Color fundus photograph — 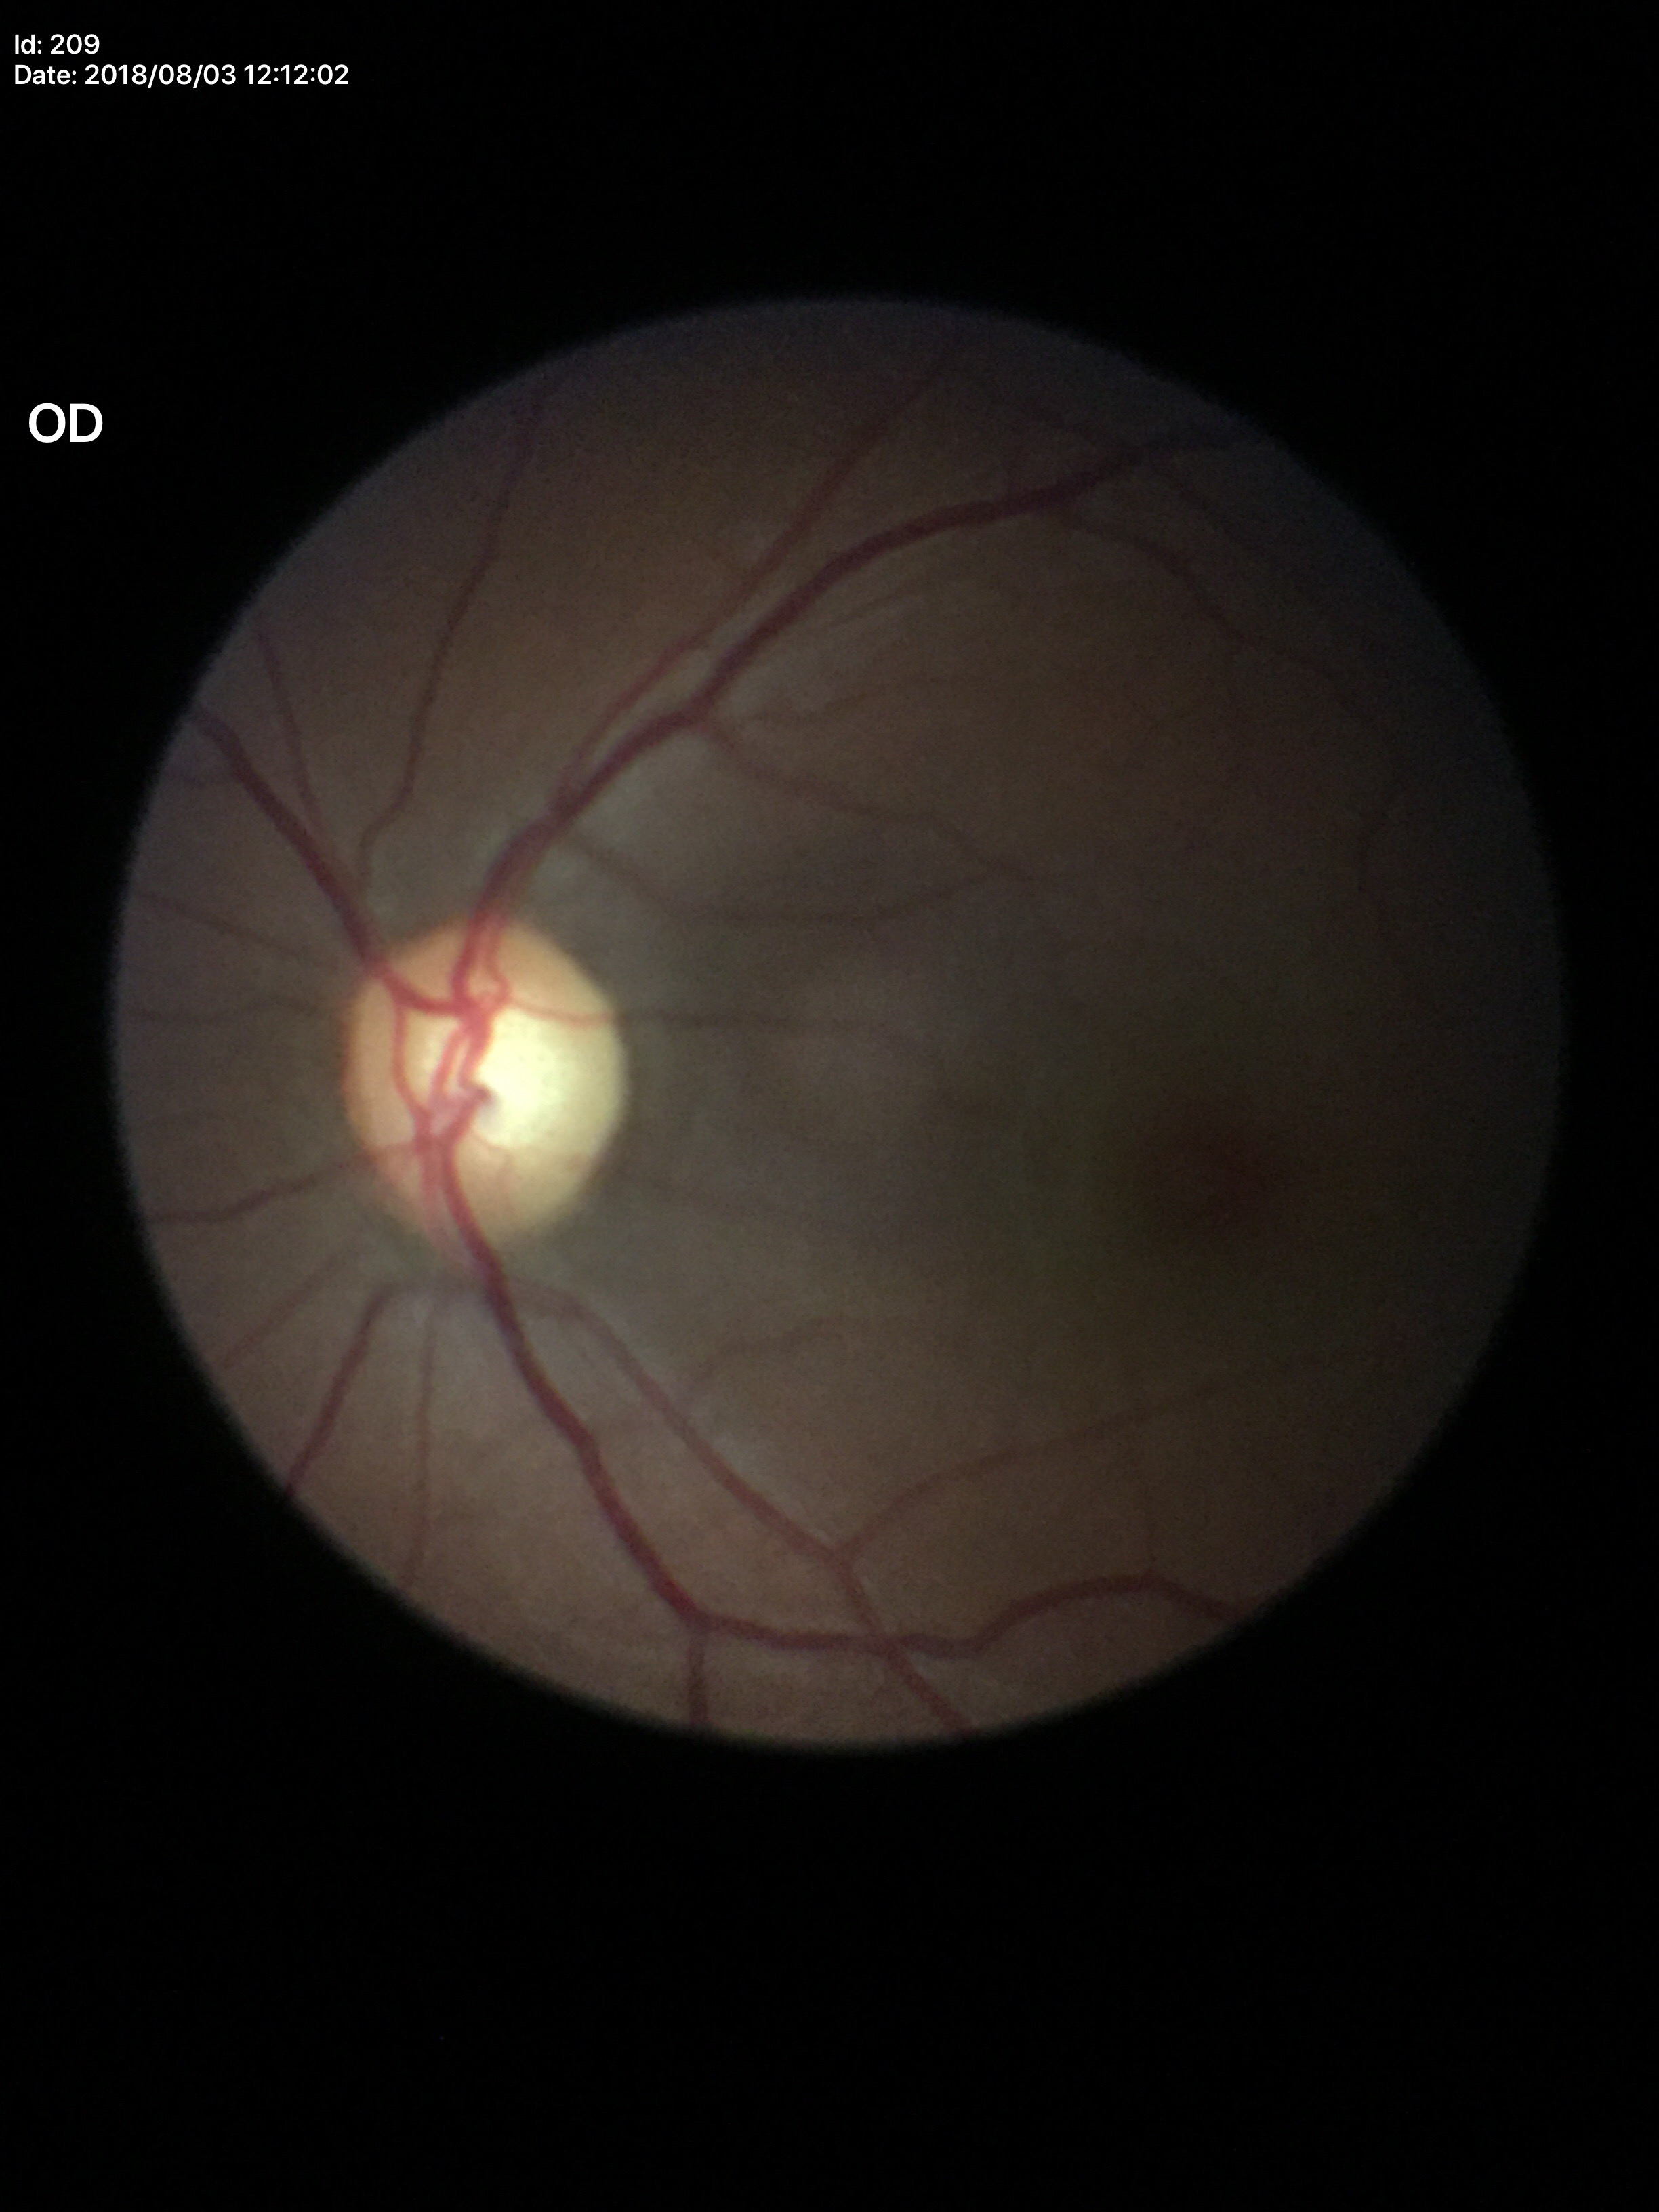
{"glaucoma_decision": "no suspicious findings", "hcdr": "0.56", "acdr": "0.31", "vcdr": "0.55"}